Clarity RetCam 3, 130° FOV · pediatric retinal photograph (wide-field) — 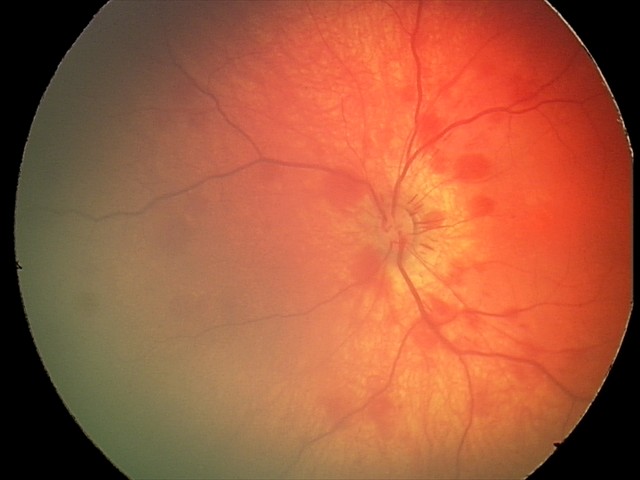
Impression = retinal hemorrhages